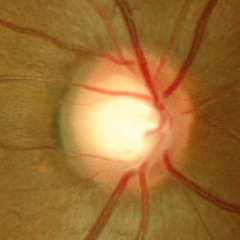 Glaucoma diagnosis: no glaucoma.